Diabetic retinopathy graded by the modified Davis classification — 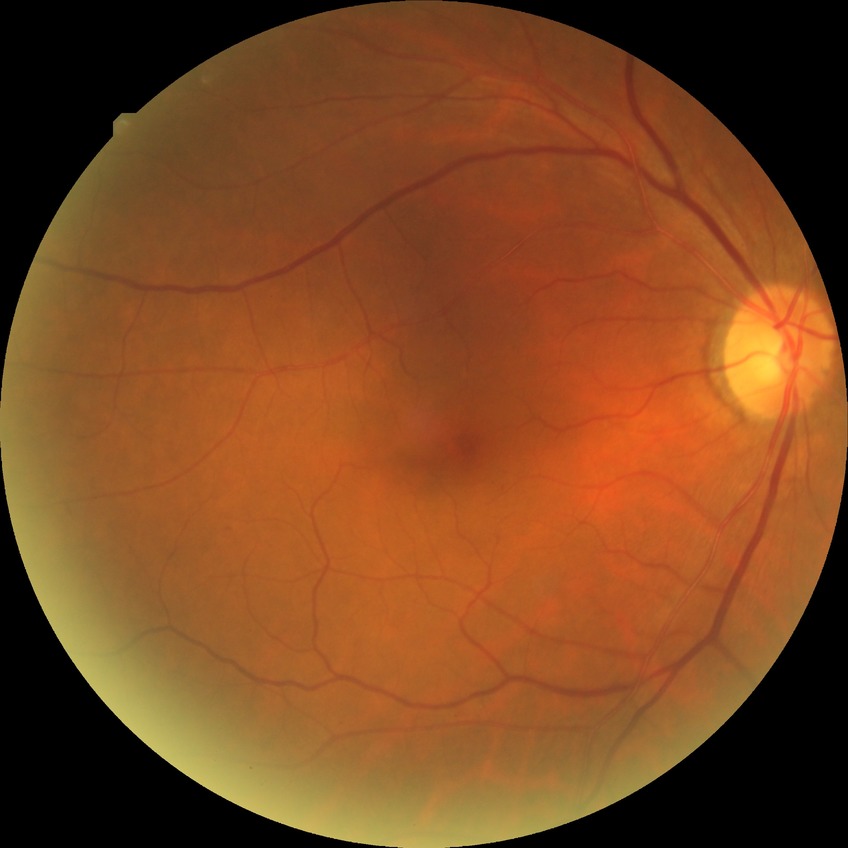 Diabetic retinopathy grade: no diabetic retinopathy.